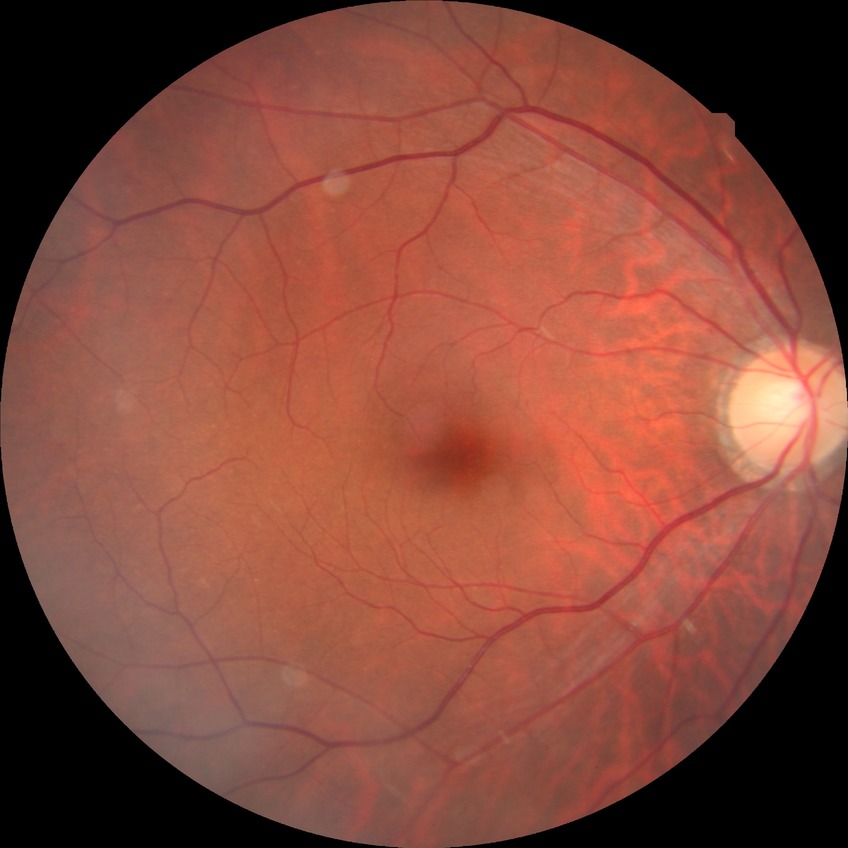
- DR severity: NDR
- DR impression: negative for DR